Modified Davis grading:
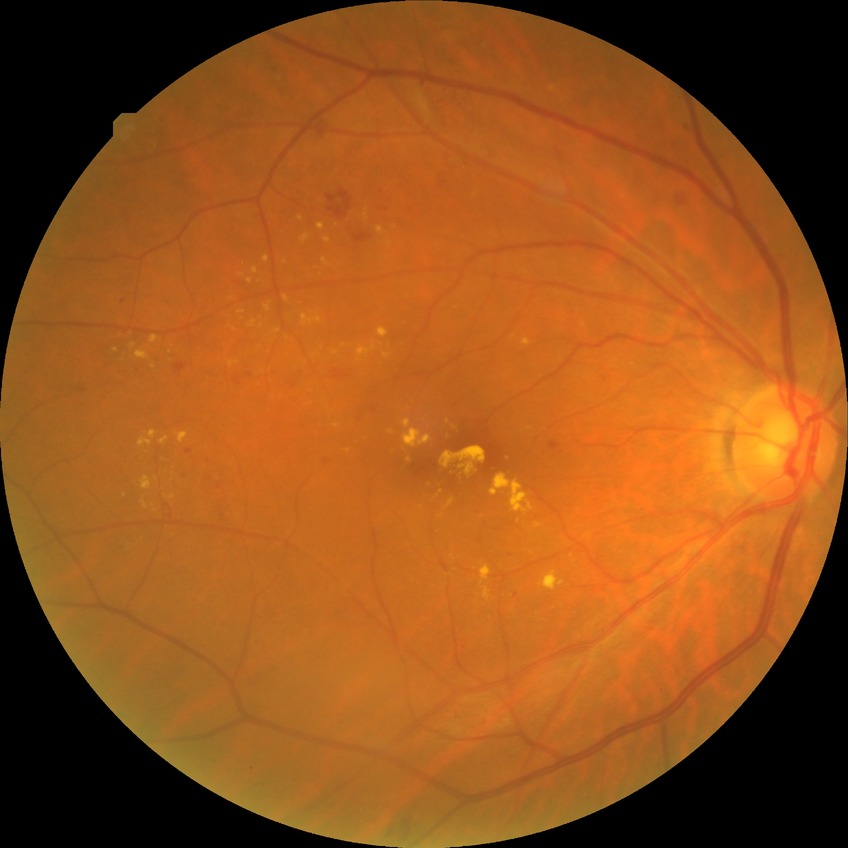 DR: SDR.